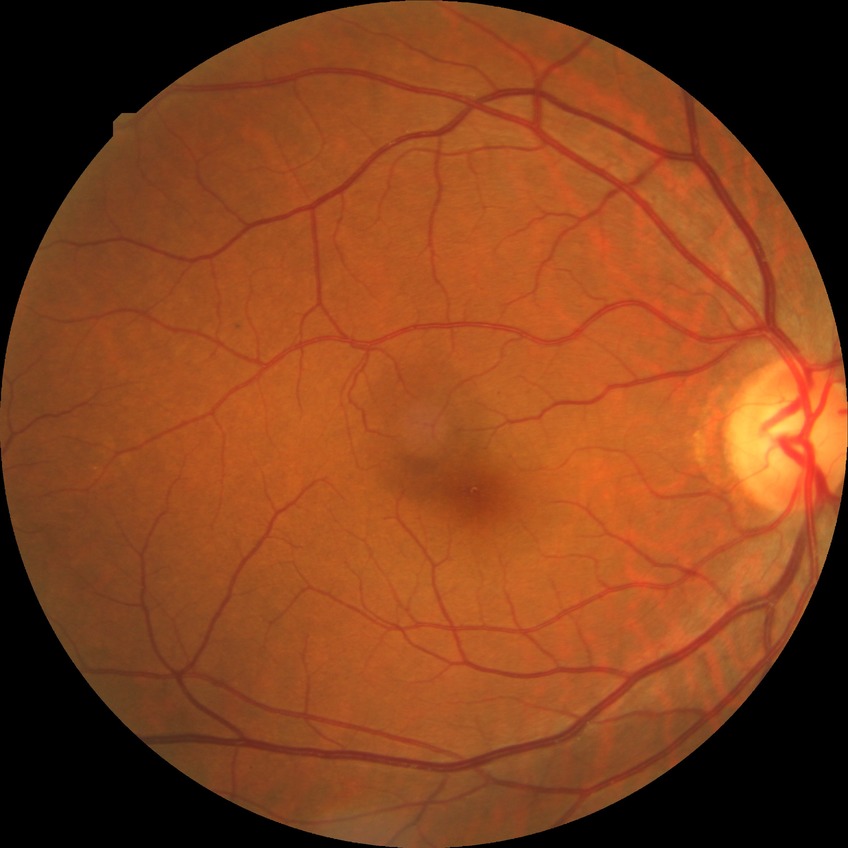 {
  "davis_grade": "simple diabetic retinopathy"
}